45° field of view — 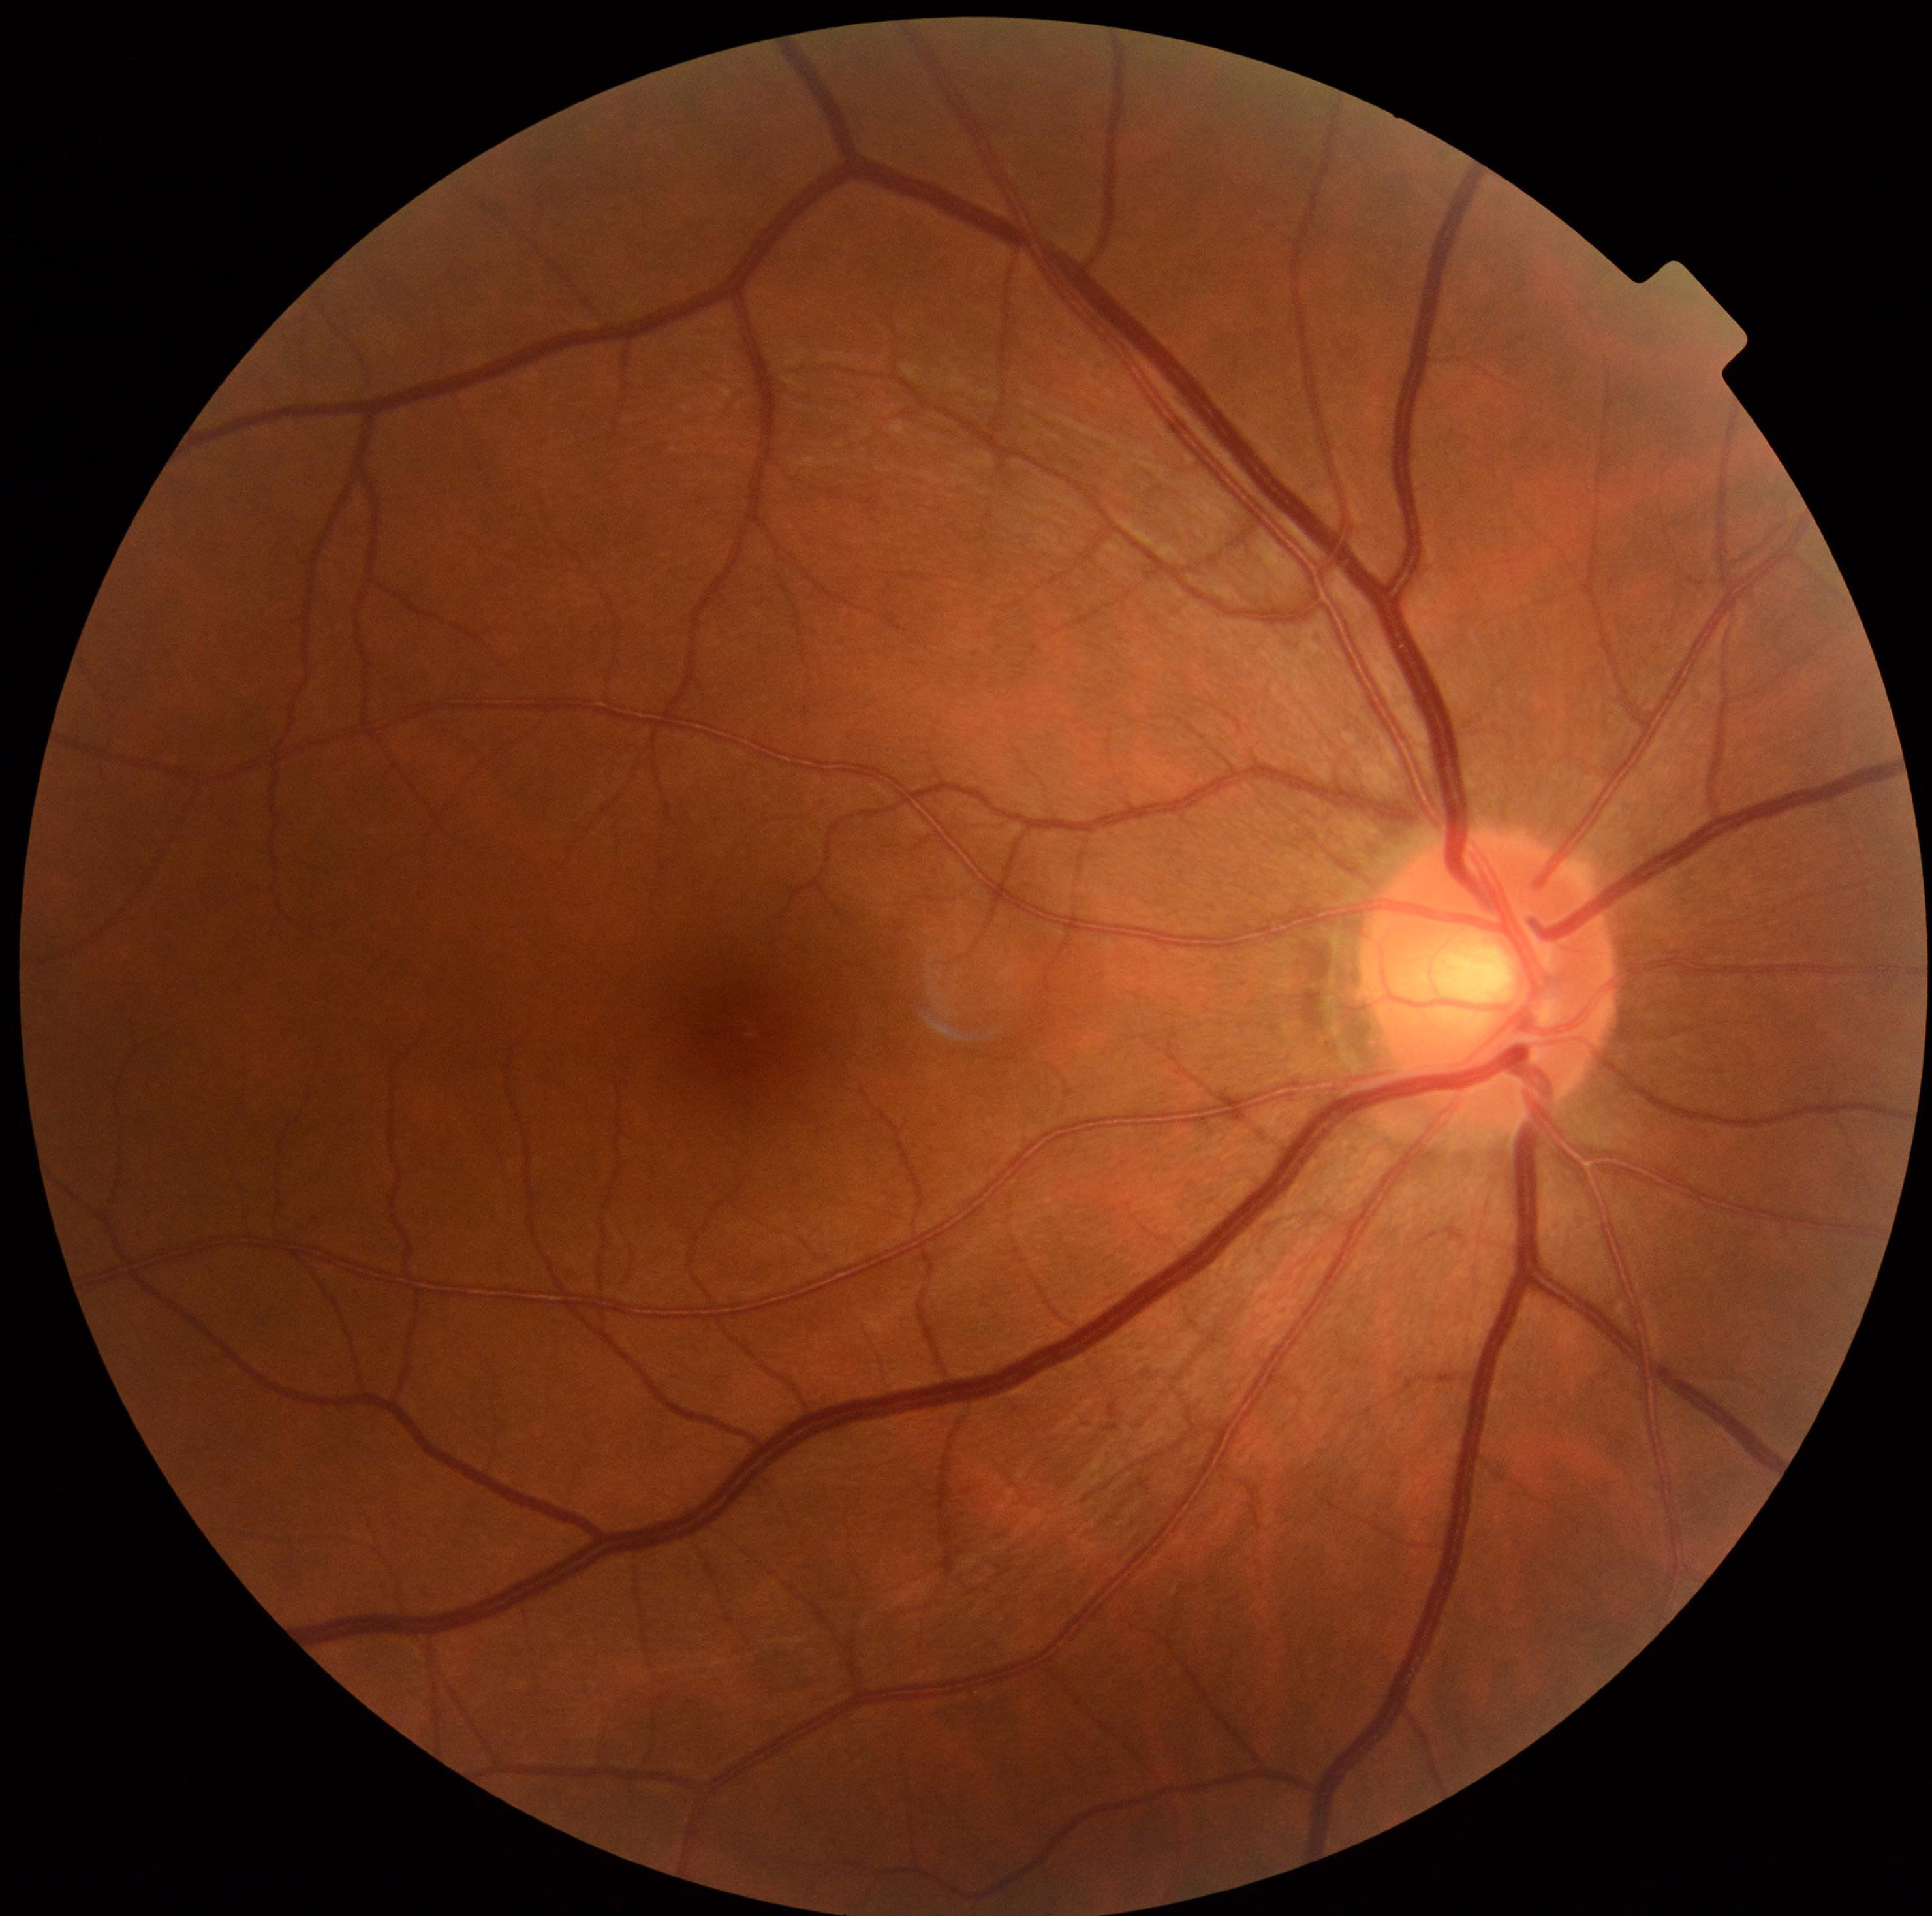
Diabetic retinopathy (DR): 0/4. No DR findings.